Retinal fundus photograph · 2212 x 1672 pixels · 45° FOV — 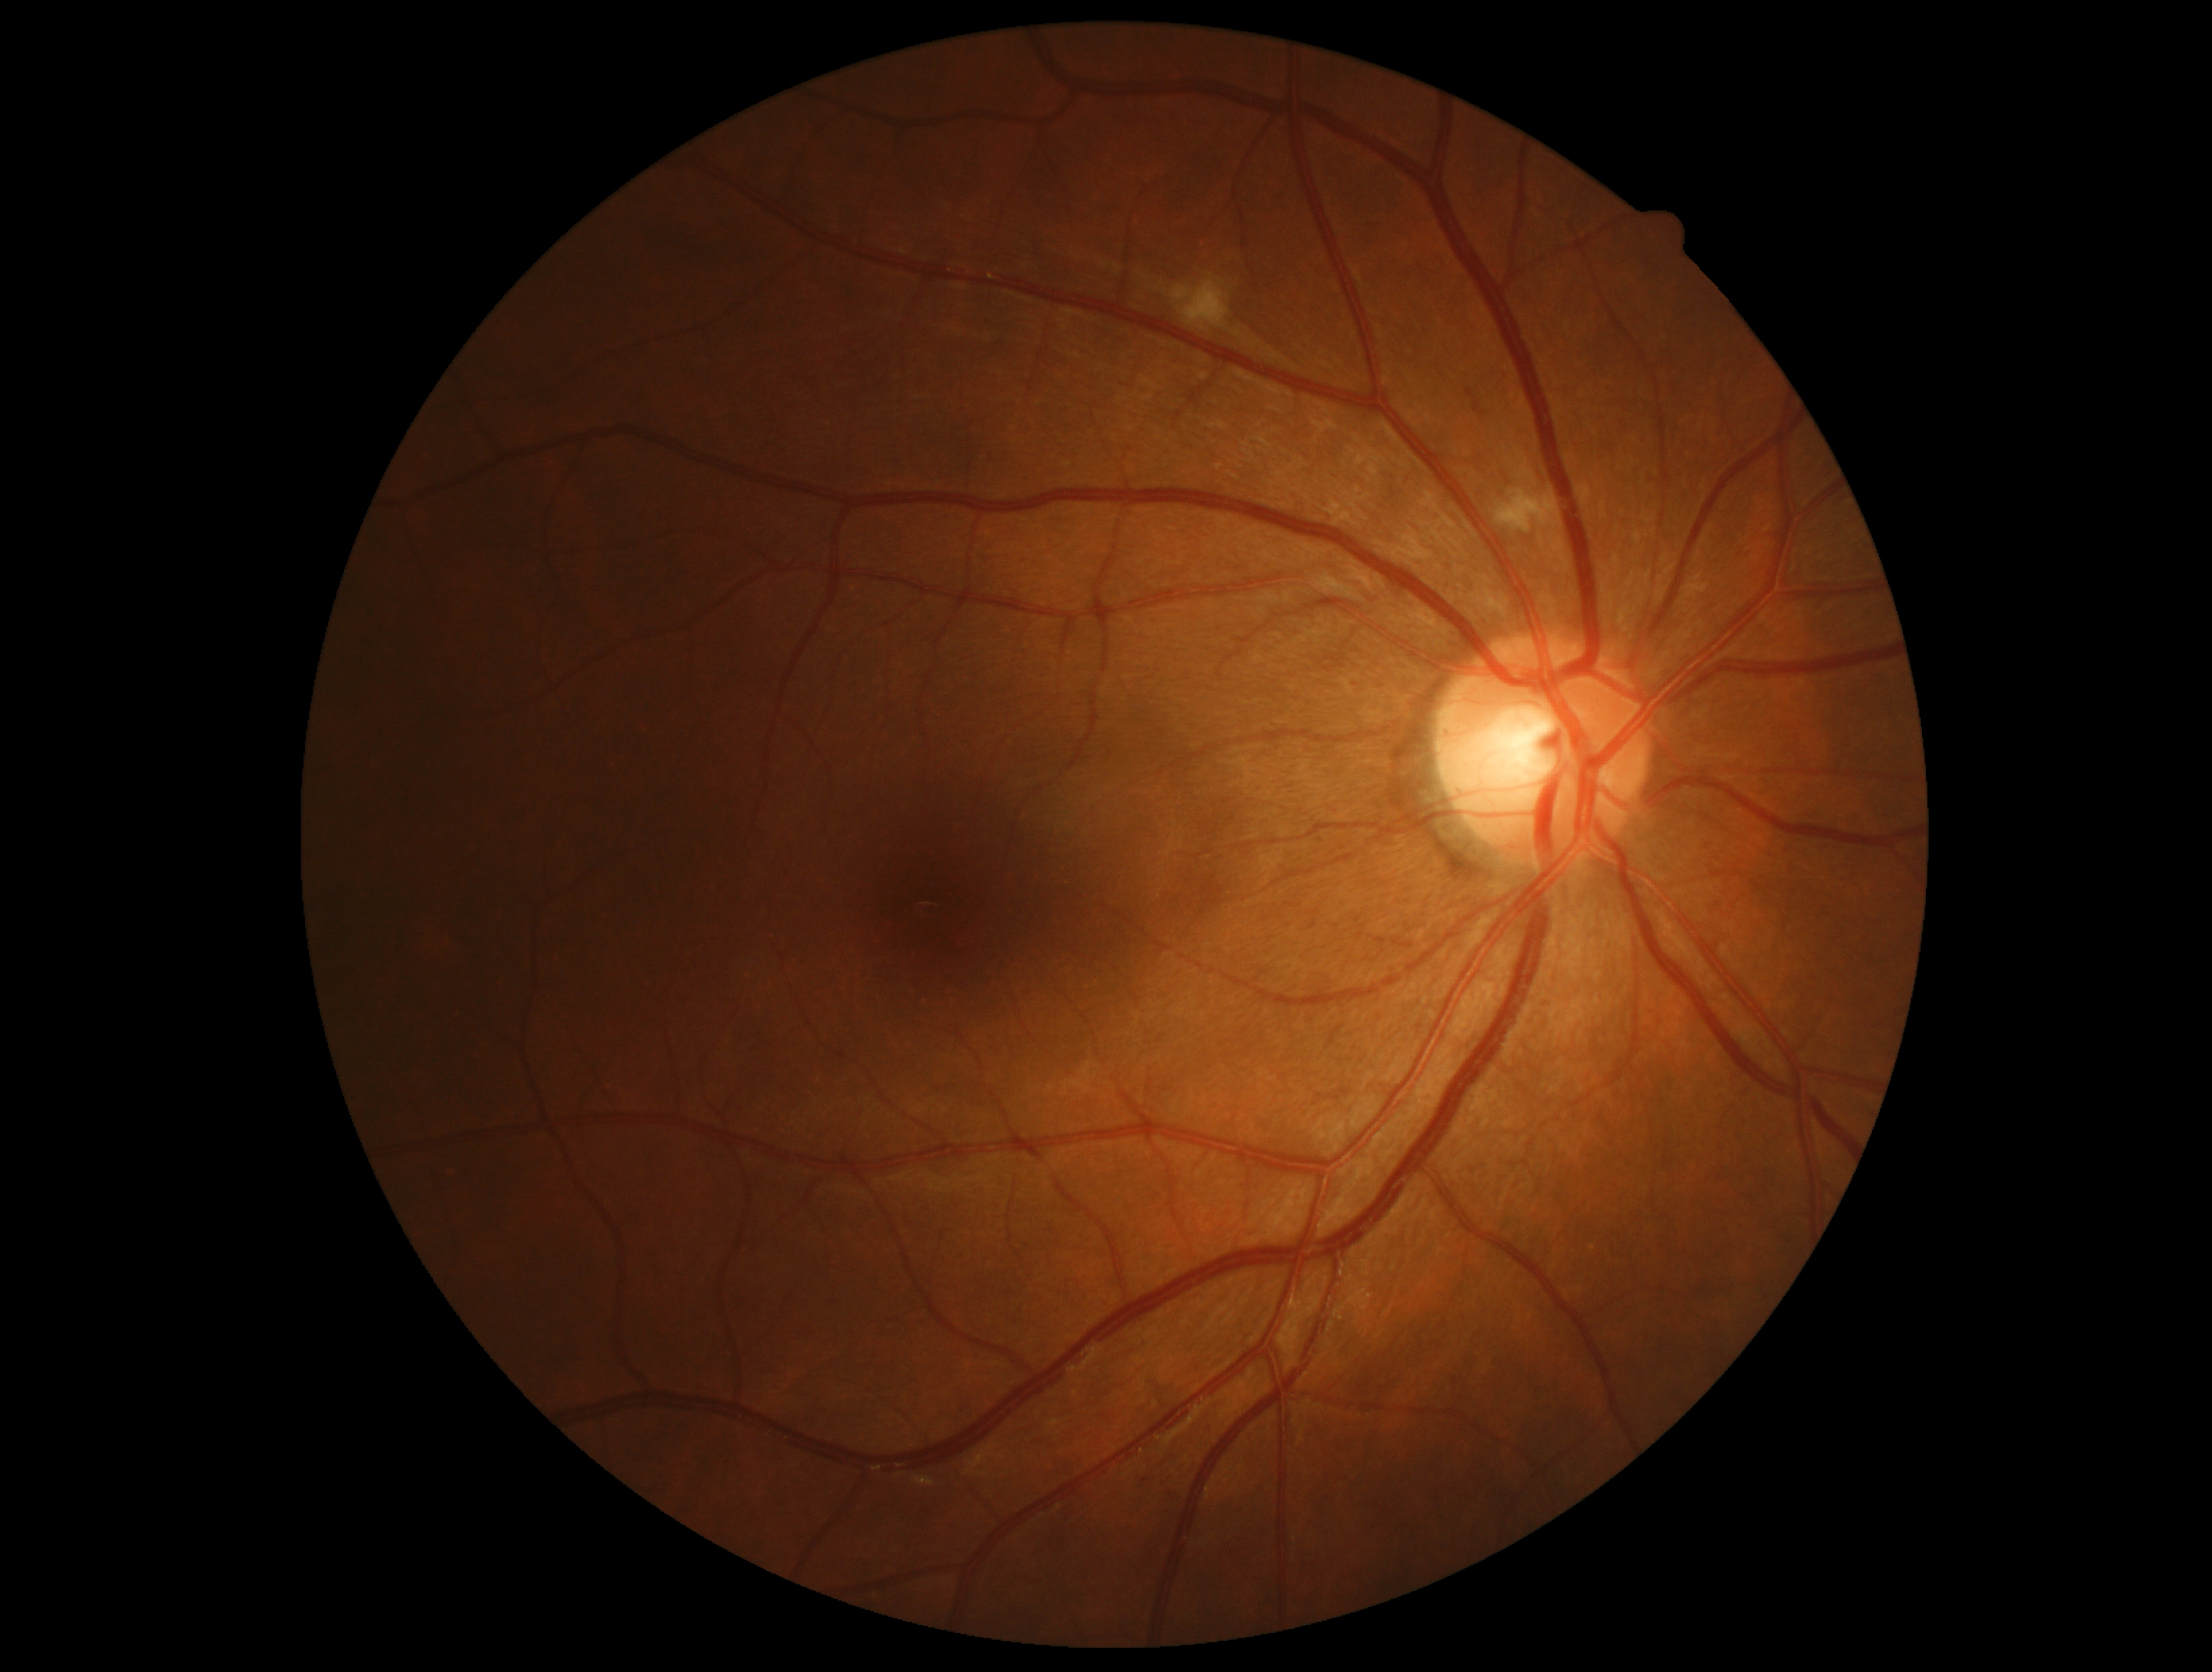

Diabetic retinopathy: grade 2.